Image size 2212x1659:
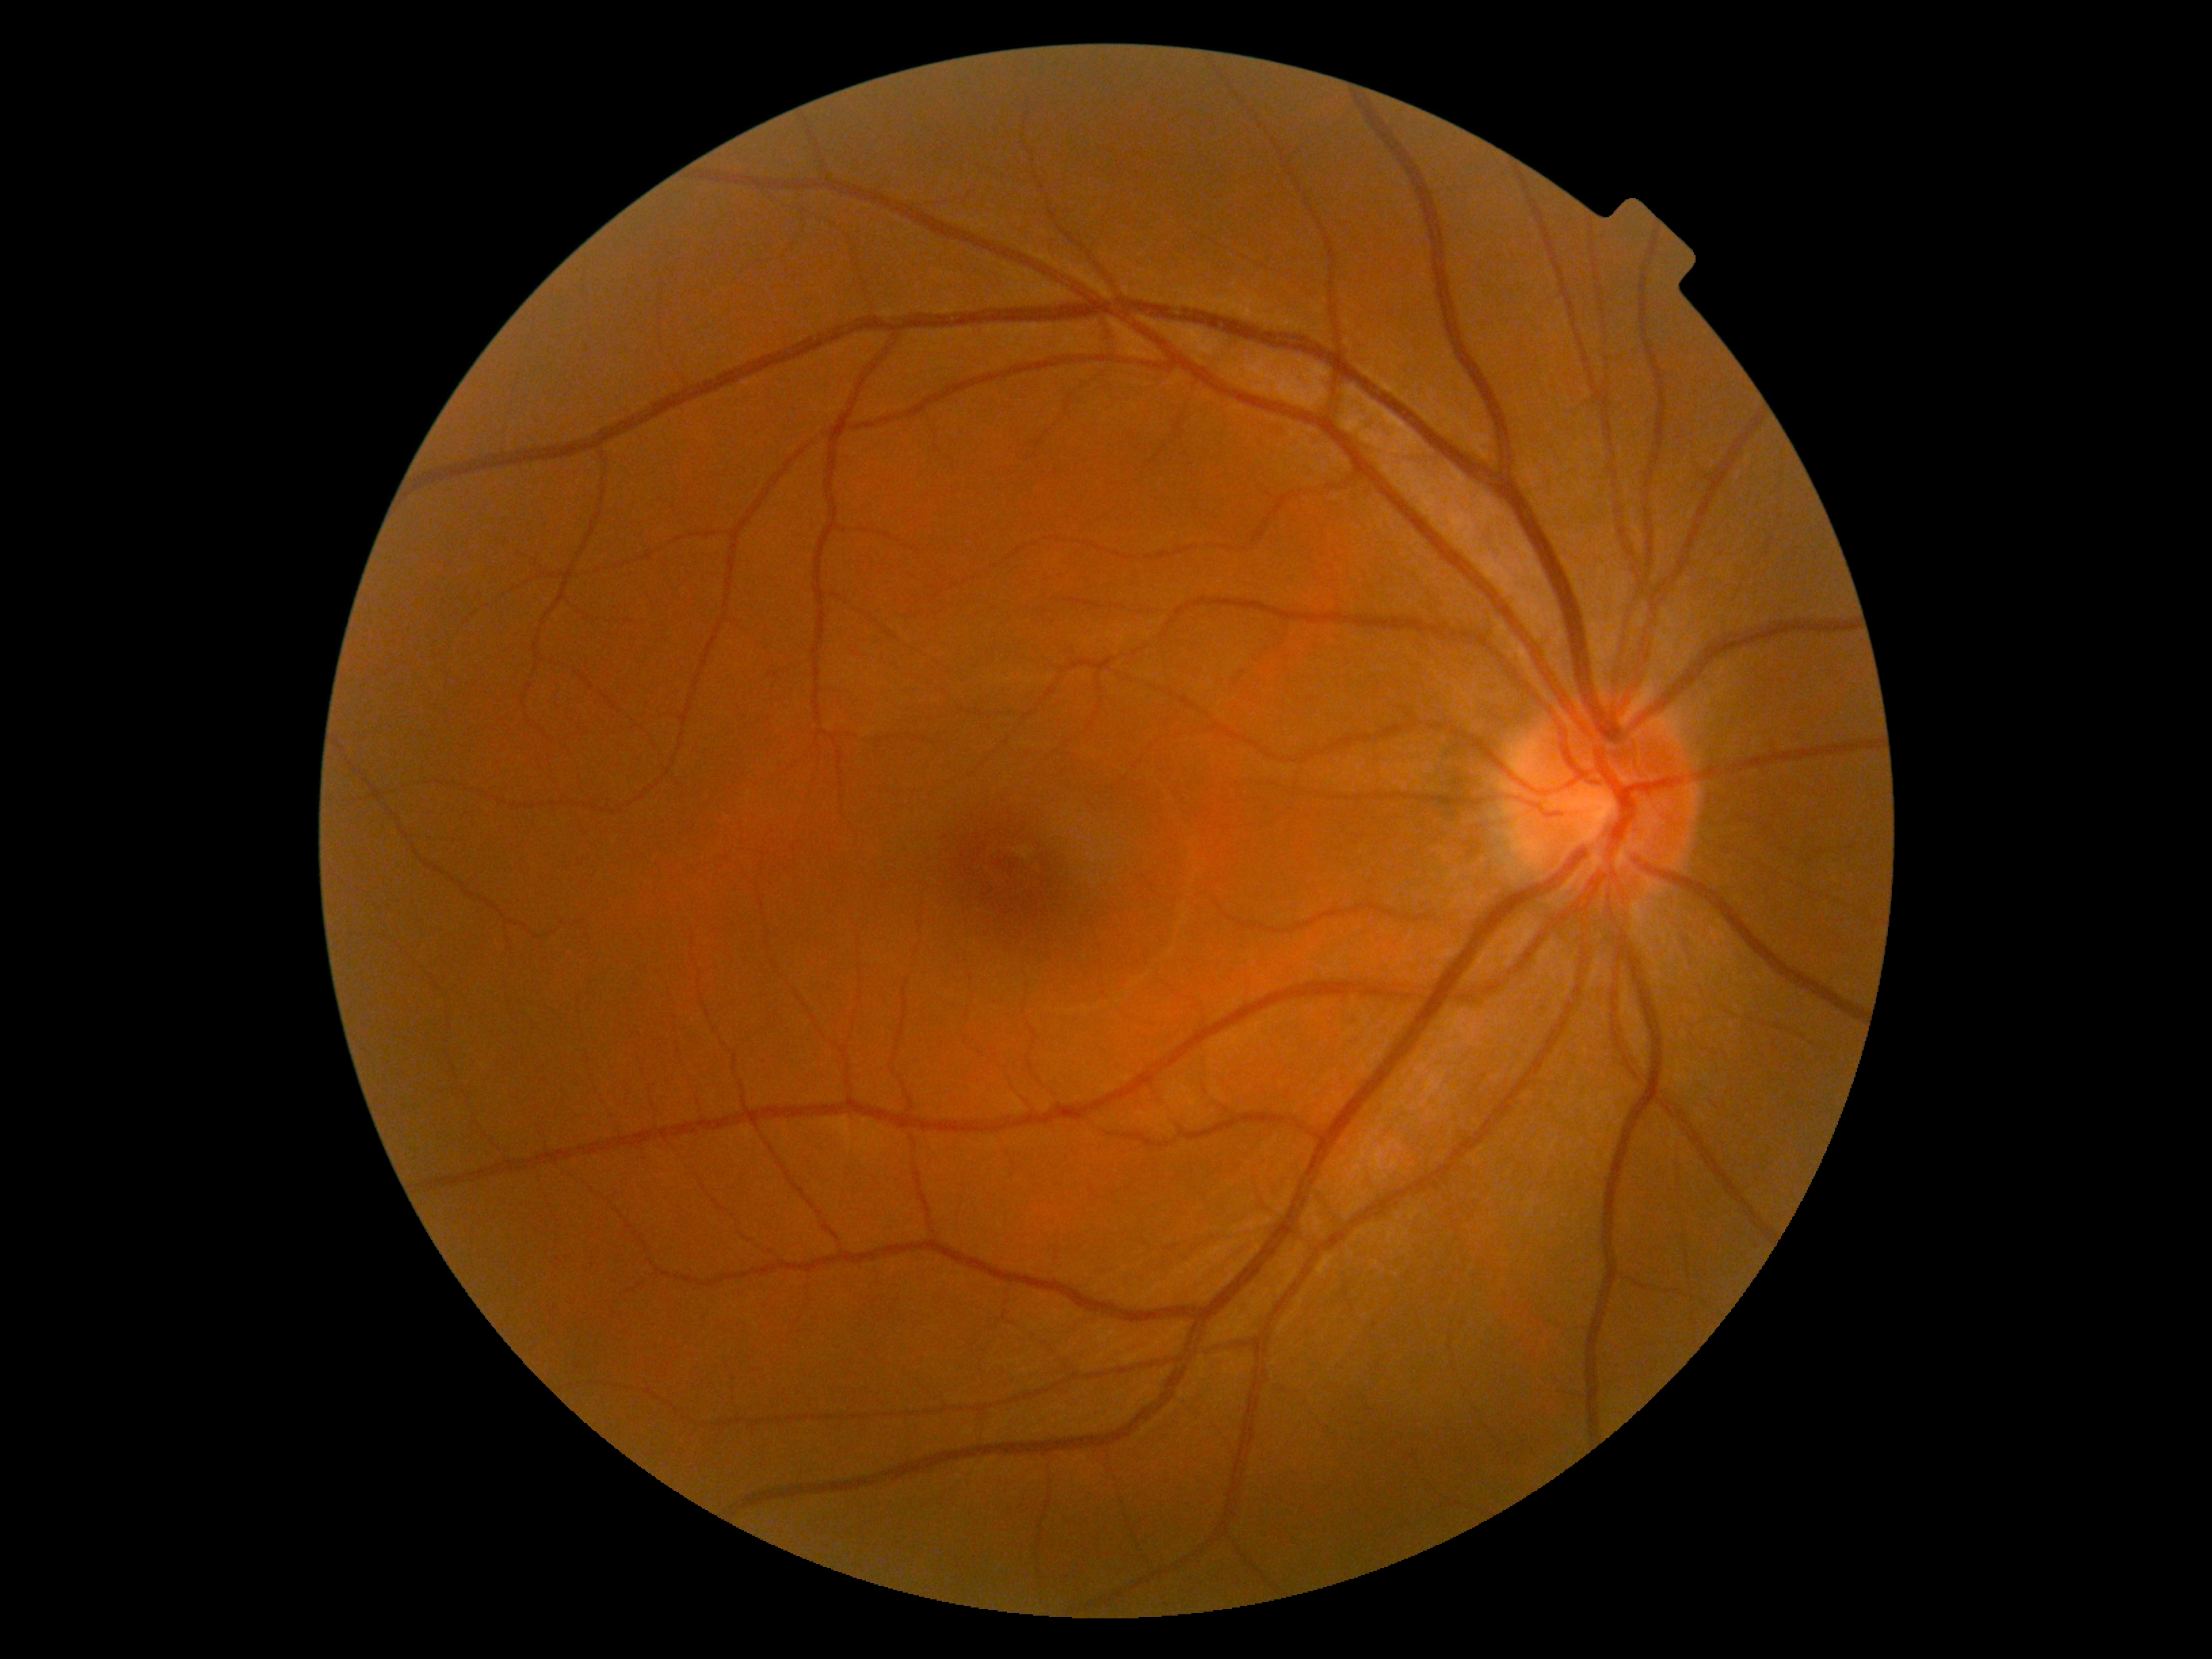
Diabetic retinopathy (DR) is grade 0 (no apparent retinopathy).